Dilated-pupil acquisition, image size 2228x1652:
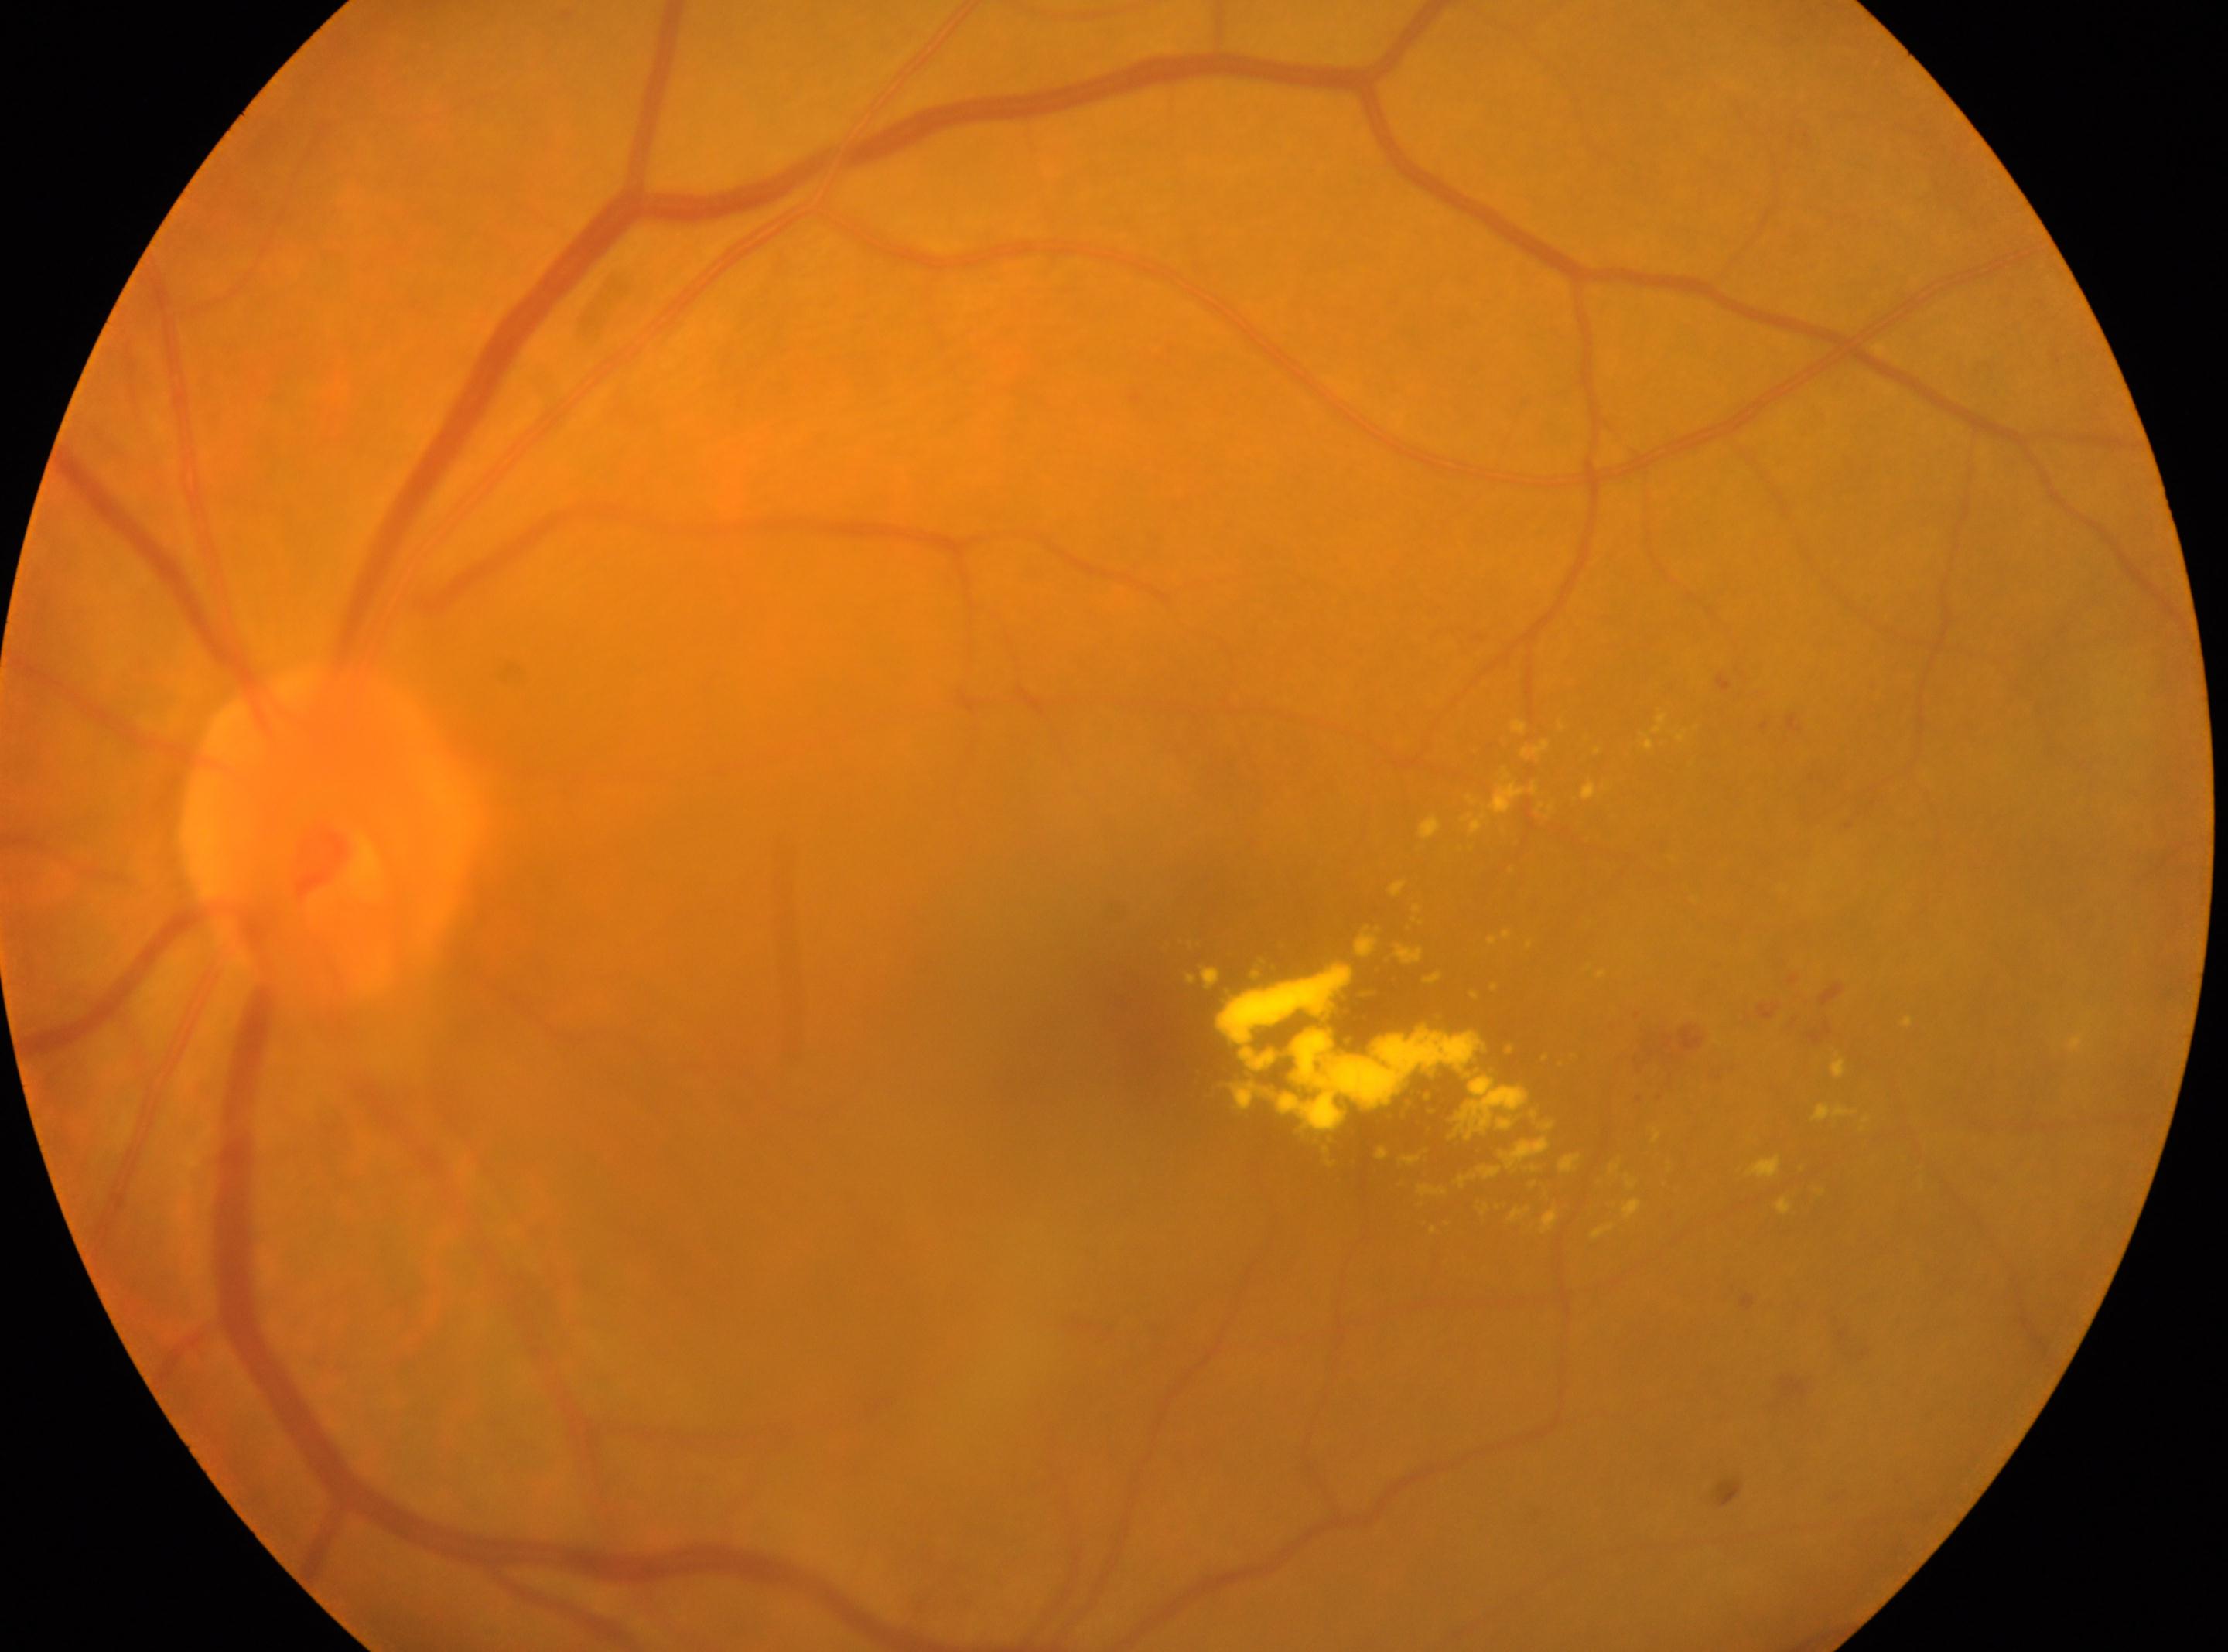

The fovea centralis is at [1164, 1032].
Retinopathy grade is moderate NPDR (2).
DR class: non-proliferative diabetic retinopathy.
This is the left eye.
Optic nerve head located at [328, 832].